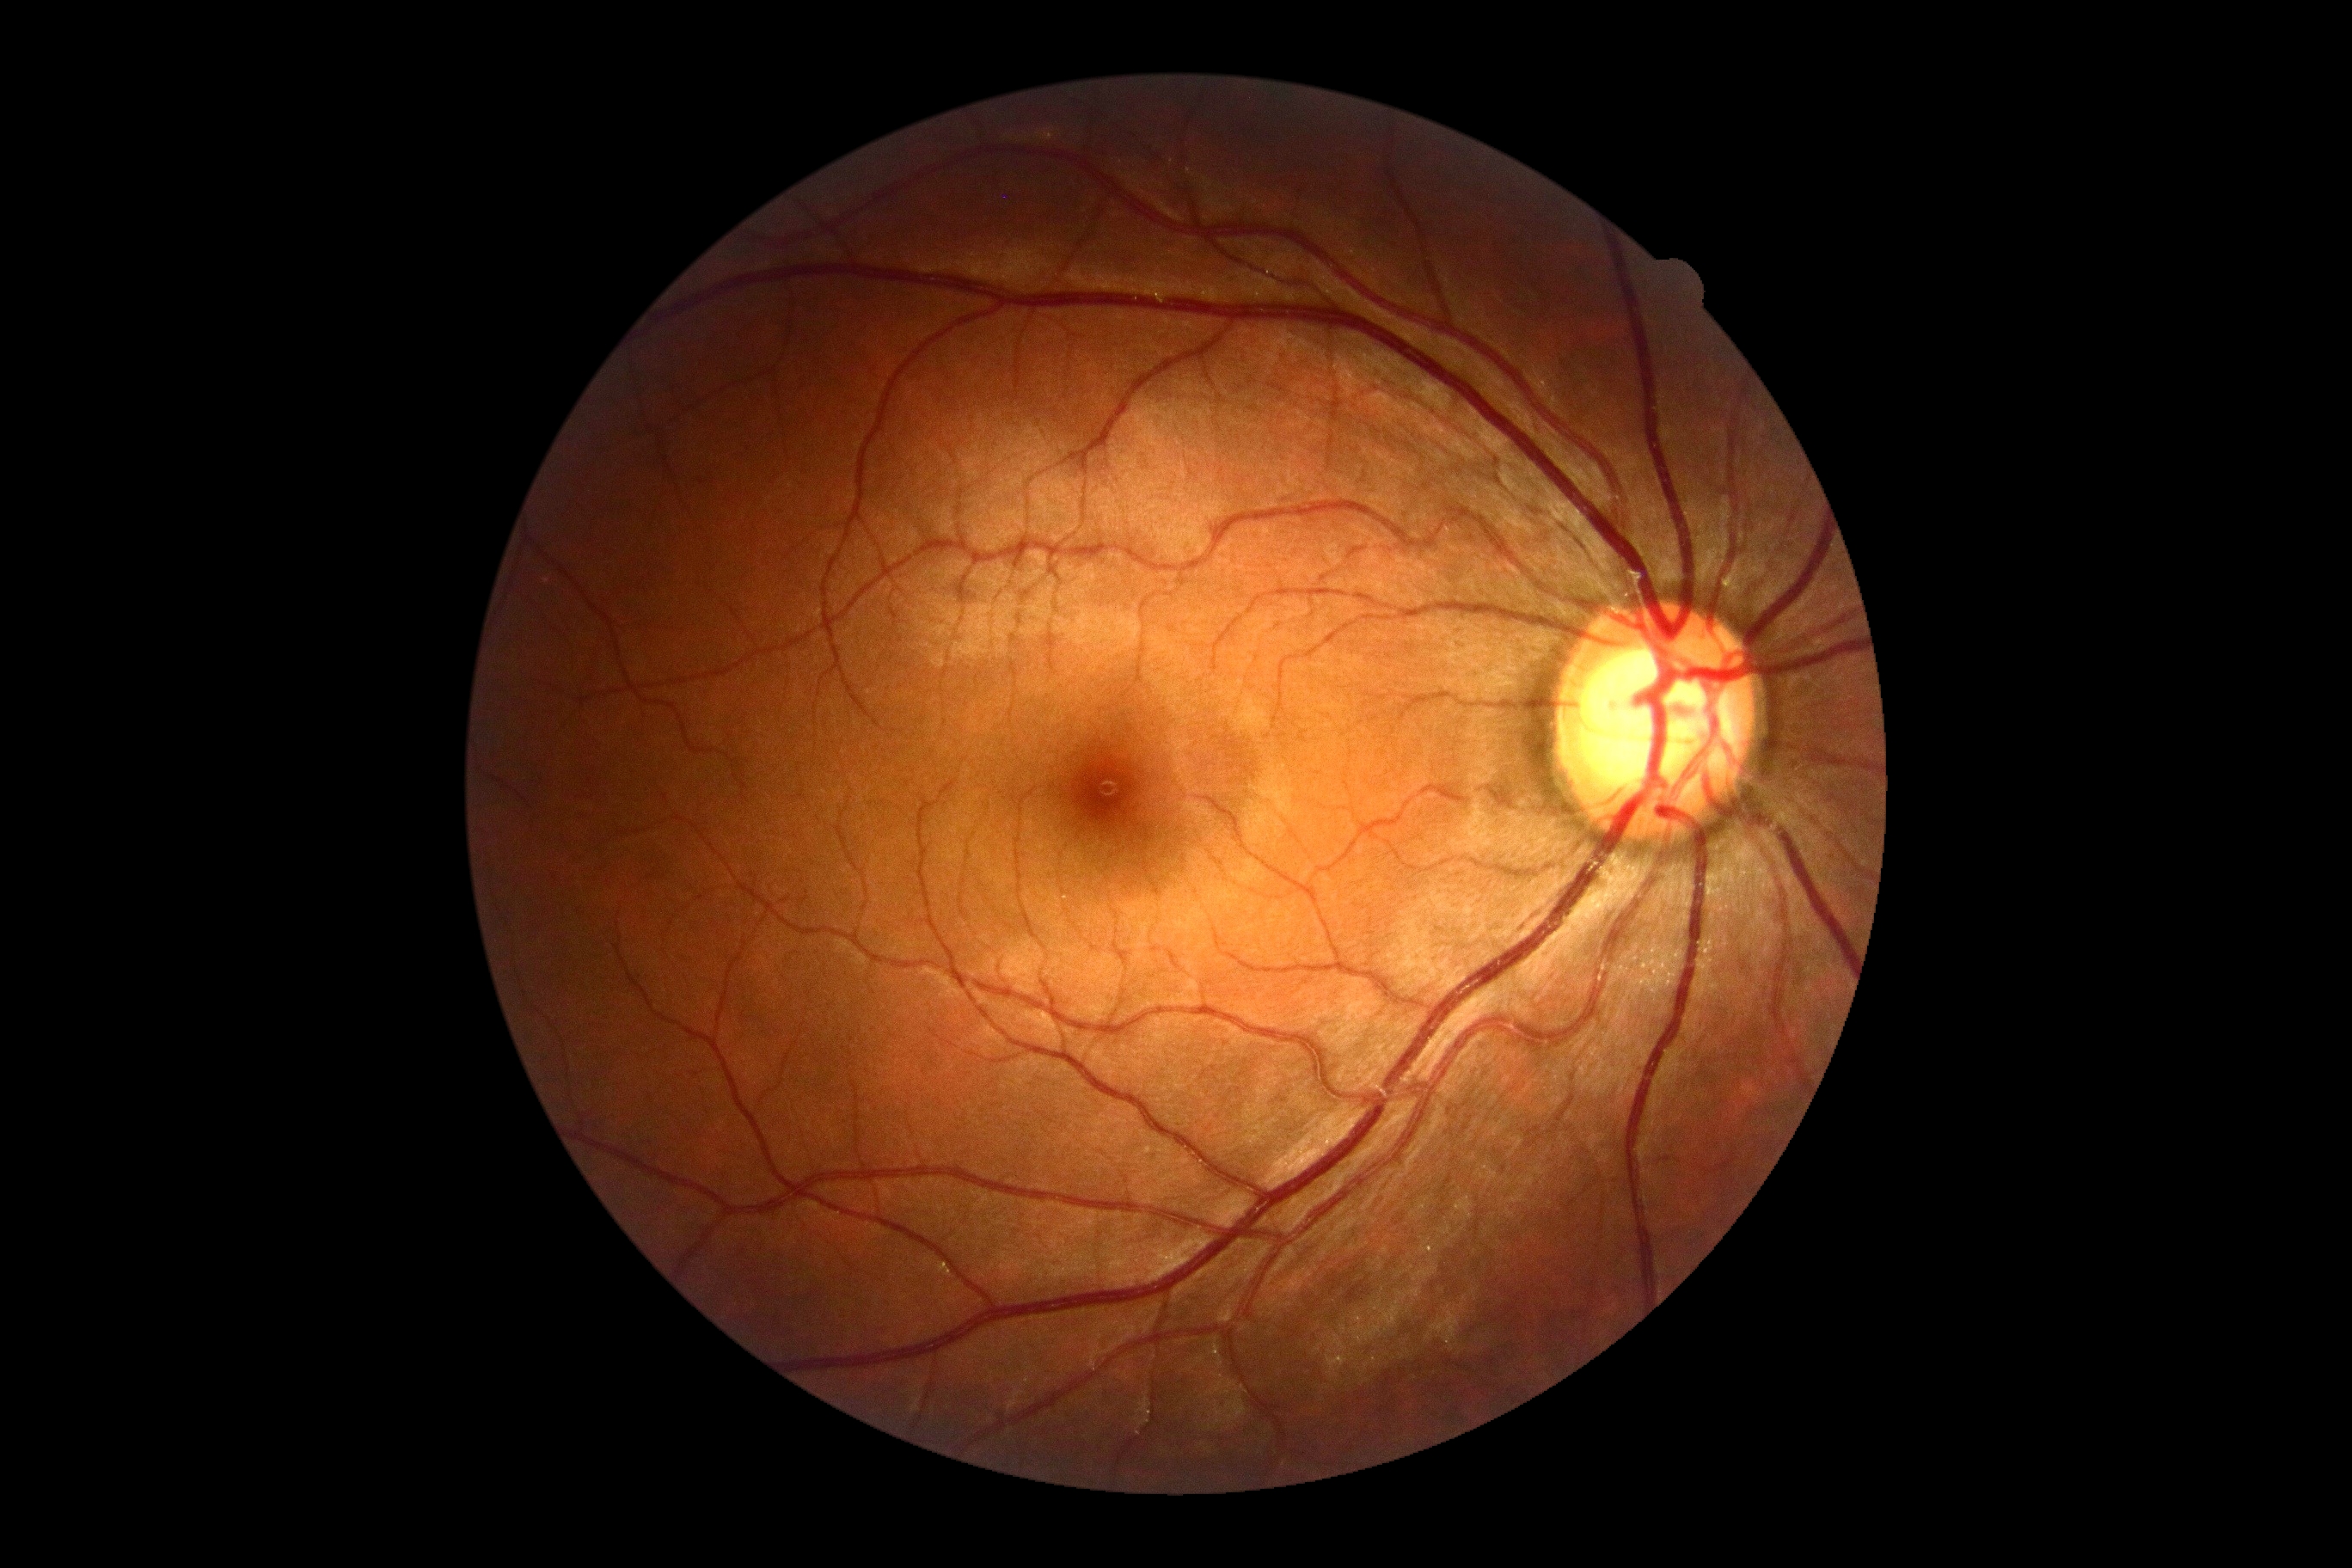

{
  "dr_grade": "no apparent diabetic retinopathy (grade 0)"
}